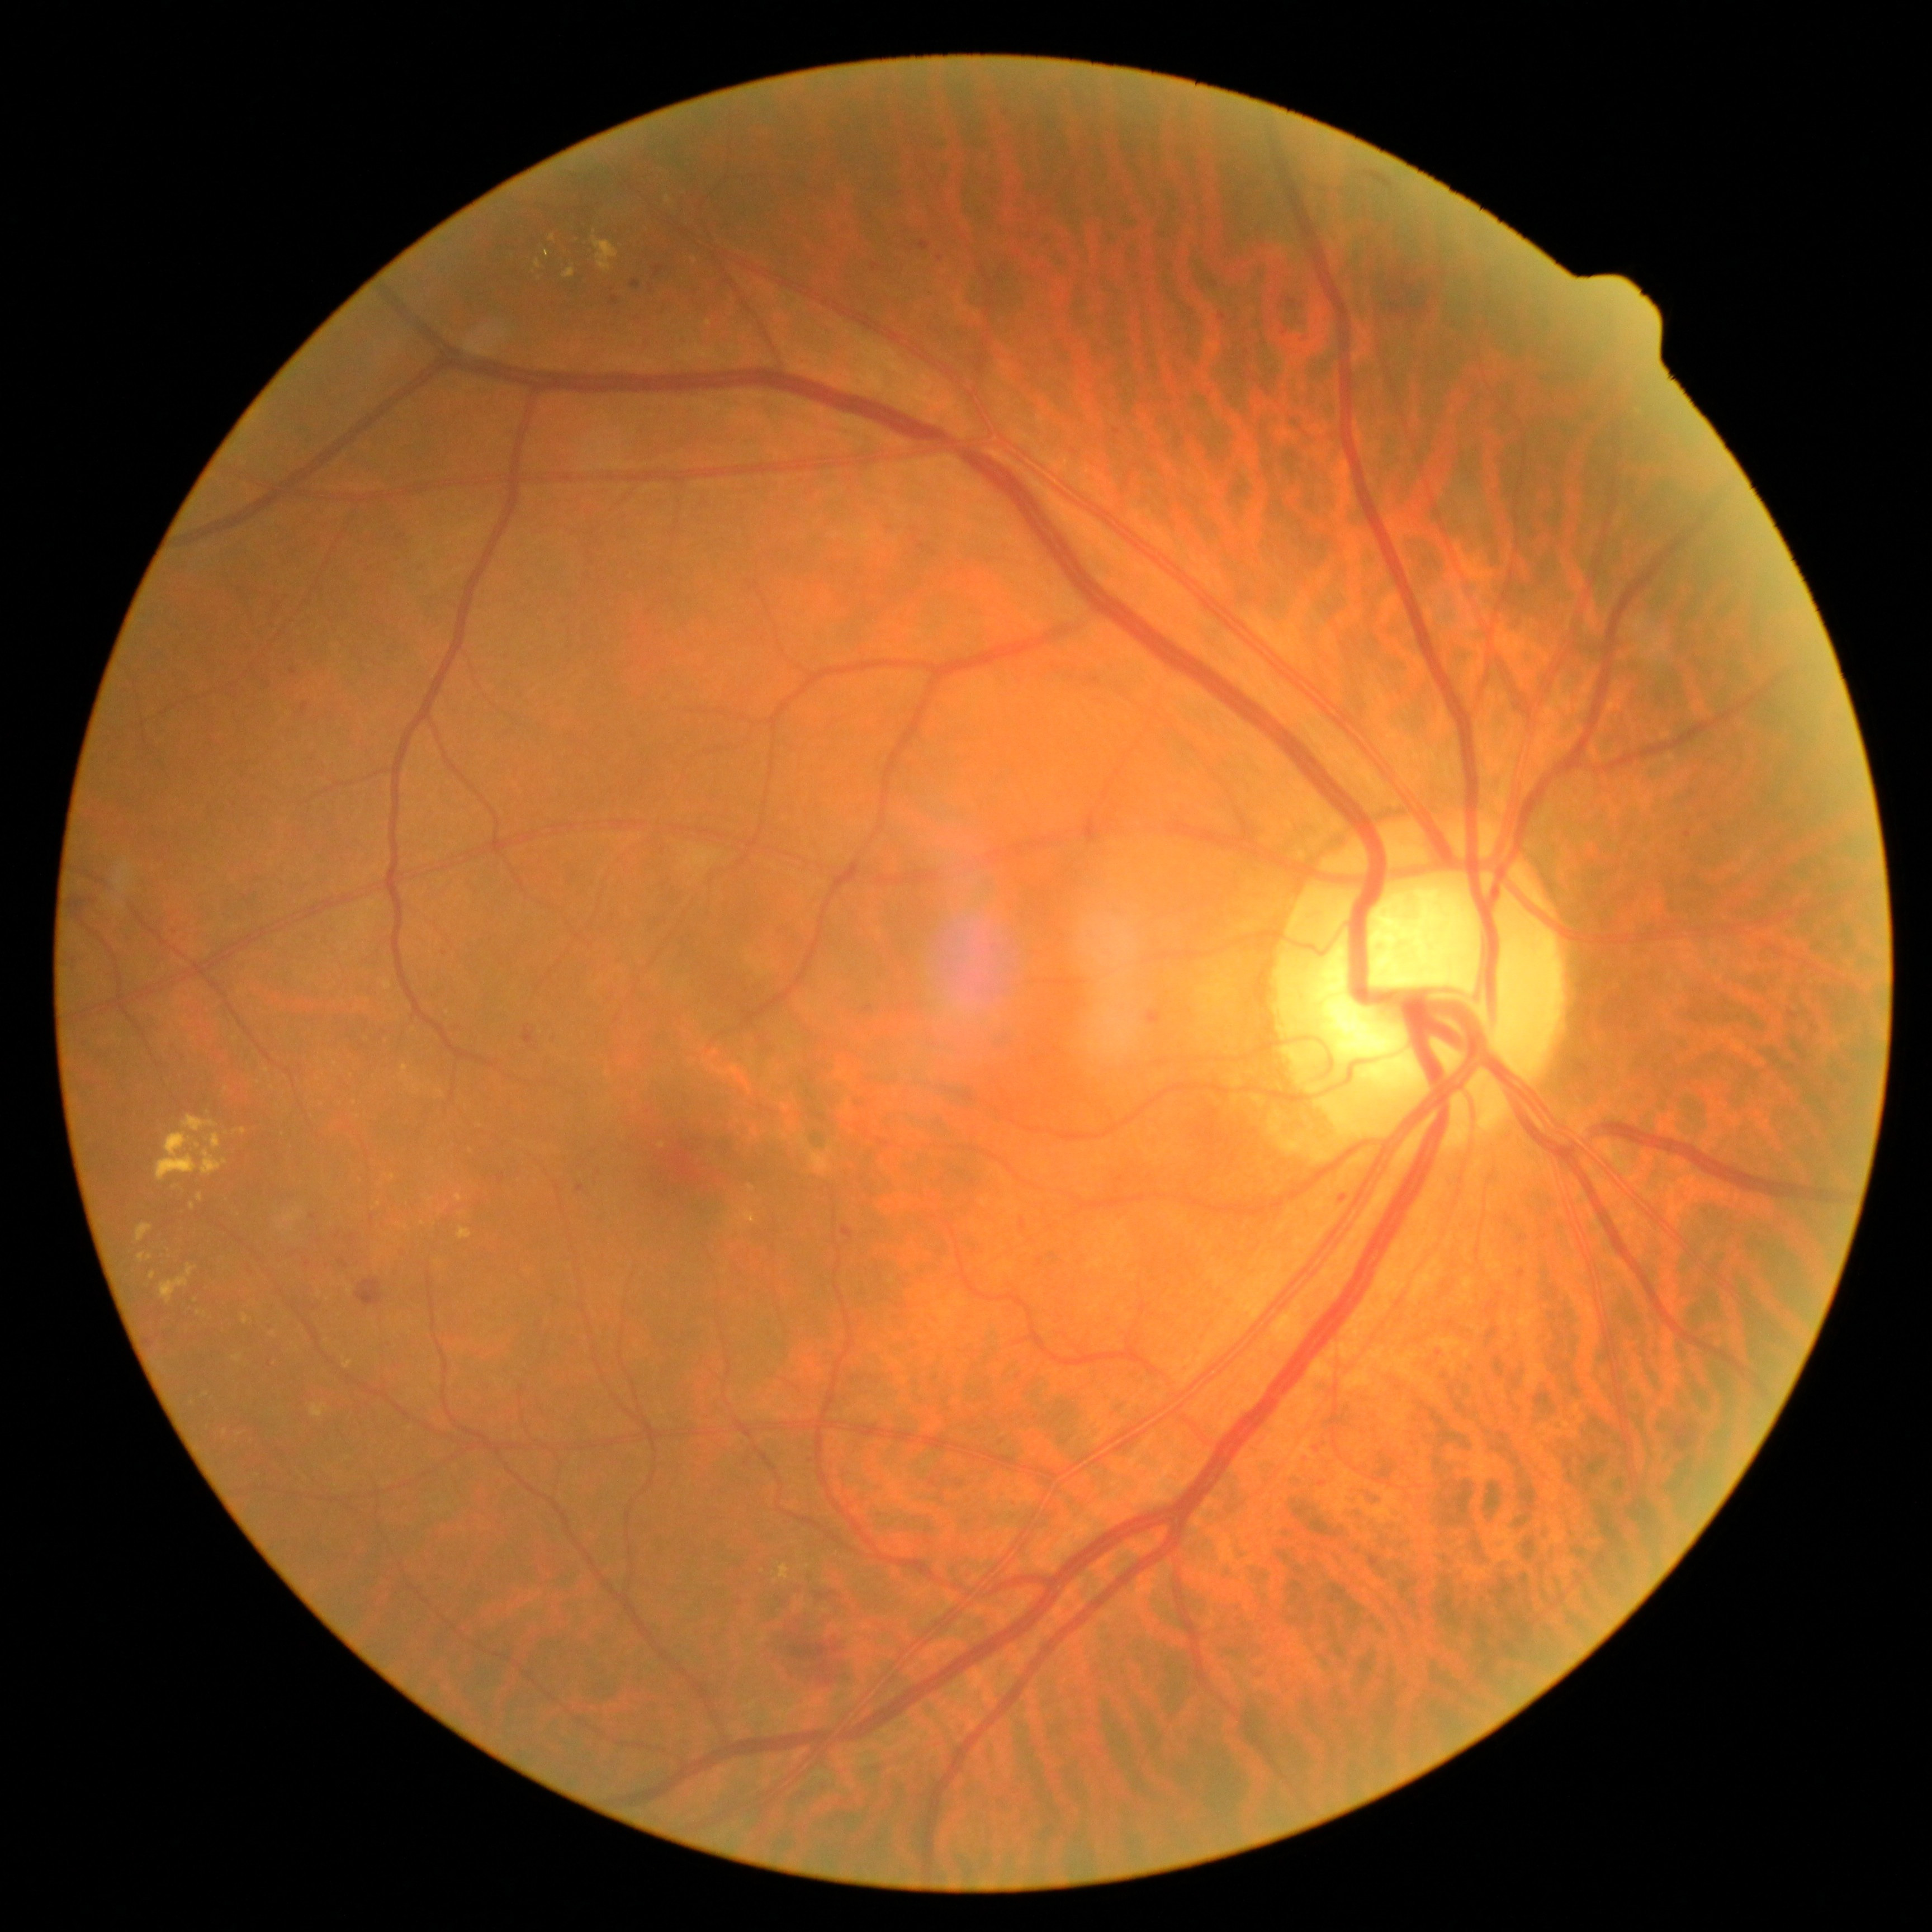 <lesions partial="true">
  <dr_grade>2</dr_grade>
  <he>box=[67, 896, 98, 926] | box=[1382, 259, 1454, 318] | box=[1360, 172, 1395, 193] | box=[783, 1630, 860, 1685] | box=[817, 1592, 842, 1599] | box=[524, 1025, 535, 1045] | box=[353, 1278, 384, 1308]</he>
  <ex partial="true">box=[209, 1133, 222, 1150] | box=[344, 1360, 353, 1369] | box=[157, 1133, 200, 1182] | box=[400, 1065, 409, 1077] | box=[458, 1227, 471, 1239] | box=[270, 1331, 278, 1337] | box=[182, 1115, 217, 1131] | box=[594, 240, 619, 272] | box=[774, 1564, 790, 1583] | box=[243, 1314, 249, 1324]</ex>
  <ex_small>(152,1275) | (417,1092) | (227,1089) | (547,253) | (380,1204) | (393,1177) | (441,1092) | (538,264)</ex_small>
  <se />
  <ma partial="true">box=[300, 704, 309, 714] | box=[1218, 315, 1227, 323] | box=[632, 281, 641, 288] | box=[1149, 1011, 1159, 1024] | box=[1684, 832, 1692, 838] | box=[610, 297, 619, 306] | box=[338, 1259, 349, 1268] | box=[1333, 1186, 1348, 1198] | box=[1262, 387, 1272, 396]</ma>
  <ma_small>(940,258) | (1522,1273) | (268,686) | (1117,432) | (876,267)</ma_small>
</lesions>